Color fundus image · captured after pupil dilation
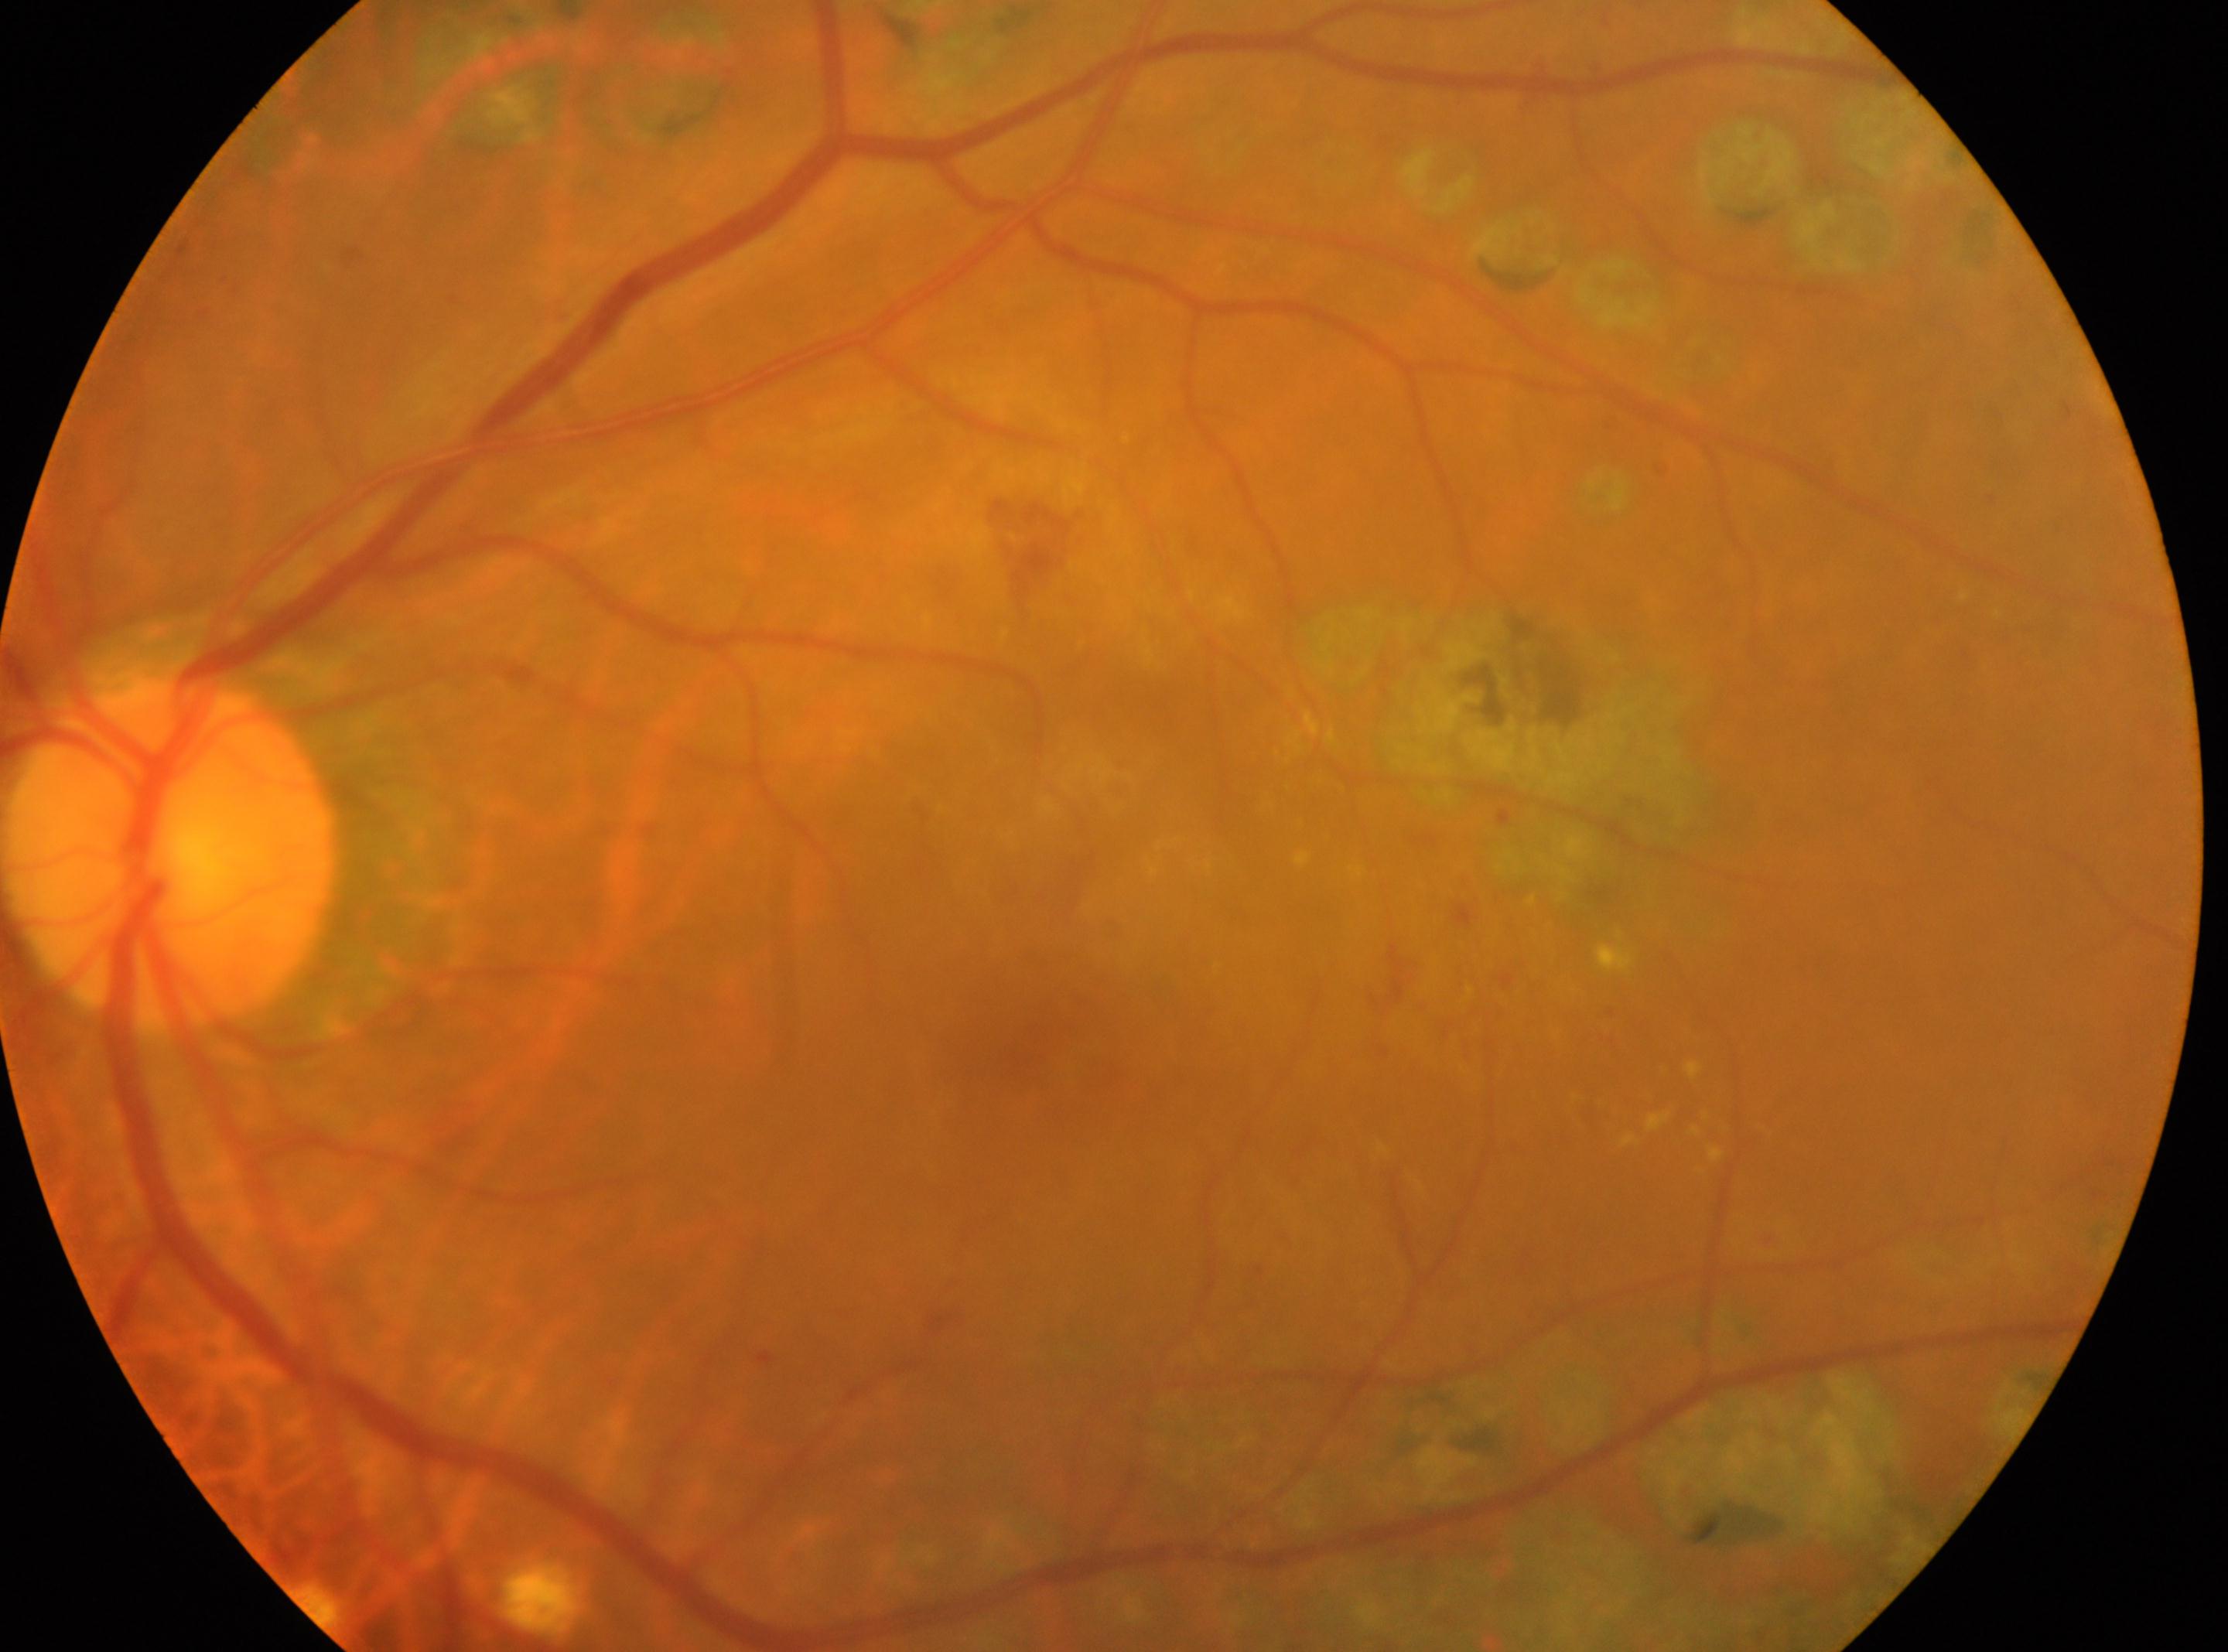

Fovea located at (1017, 1049).
Imaged eye: left eye.
Diabetic retinopathy is laser-treated DR.
Optic disk located at (170, 853).